Non-mydriatic acquisition. Fundus photo
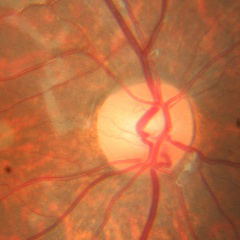
Glaucoma status: no glaucomatous changes.